848 by 848 pixels — 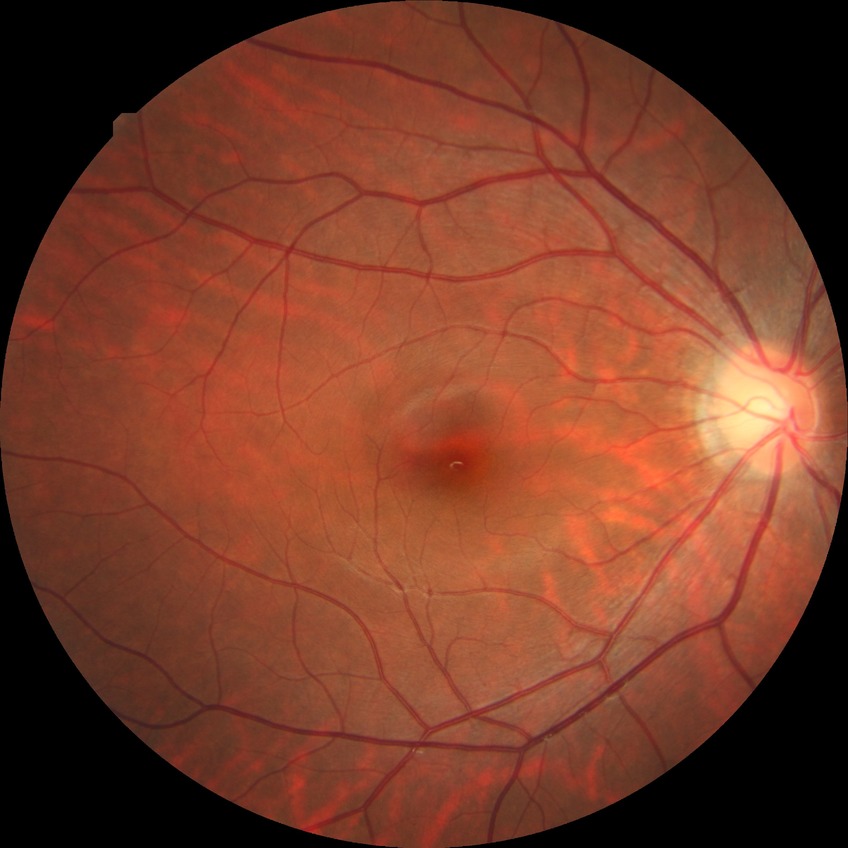
Diabetic retinopathy (DR): NDR (no diabetic retinopathy).